45° FOV.
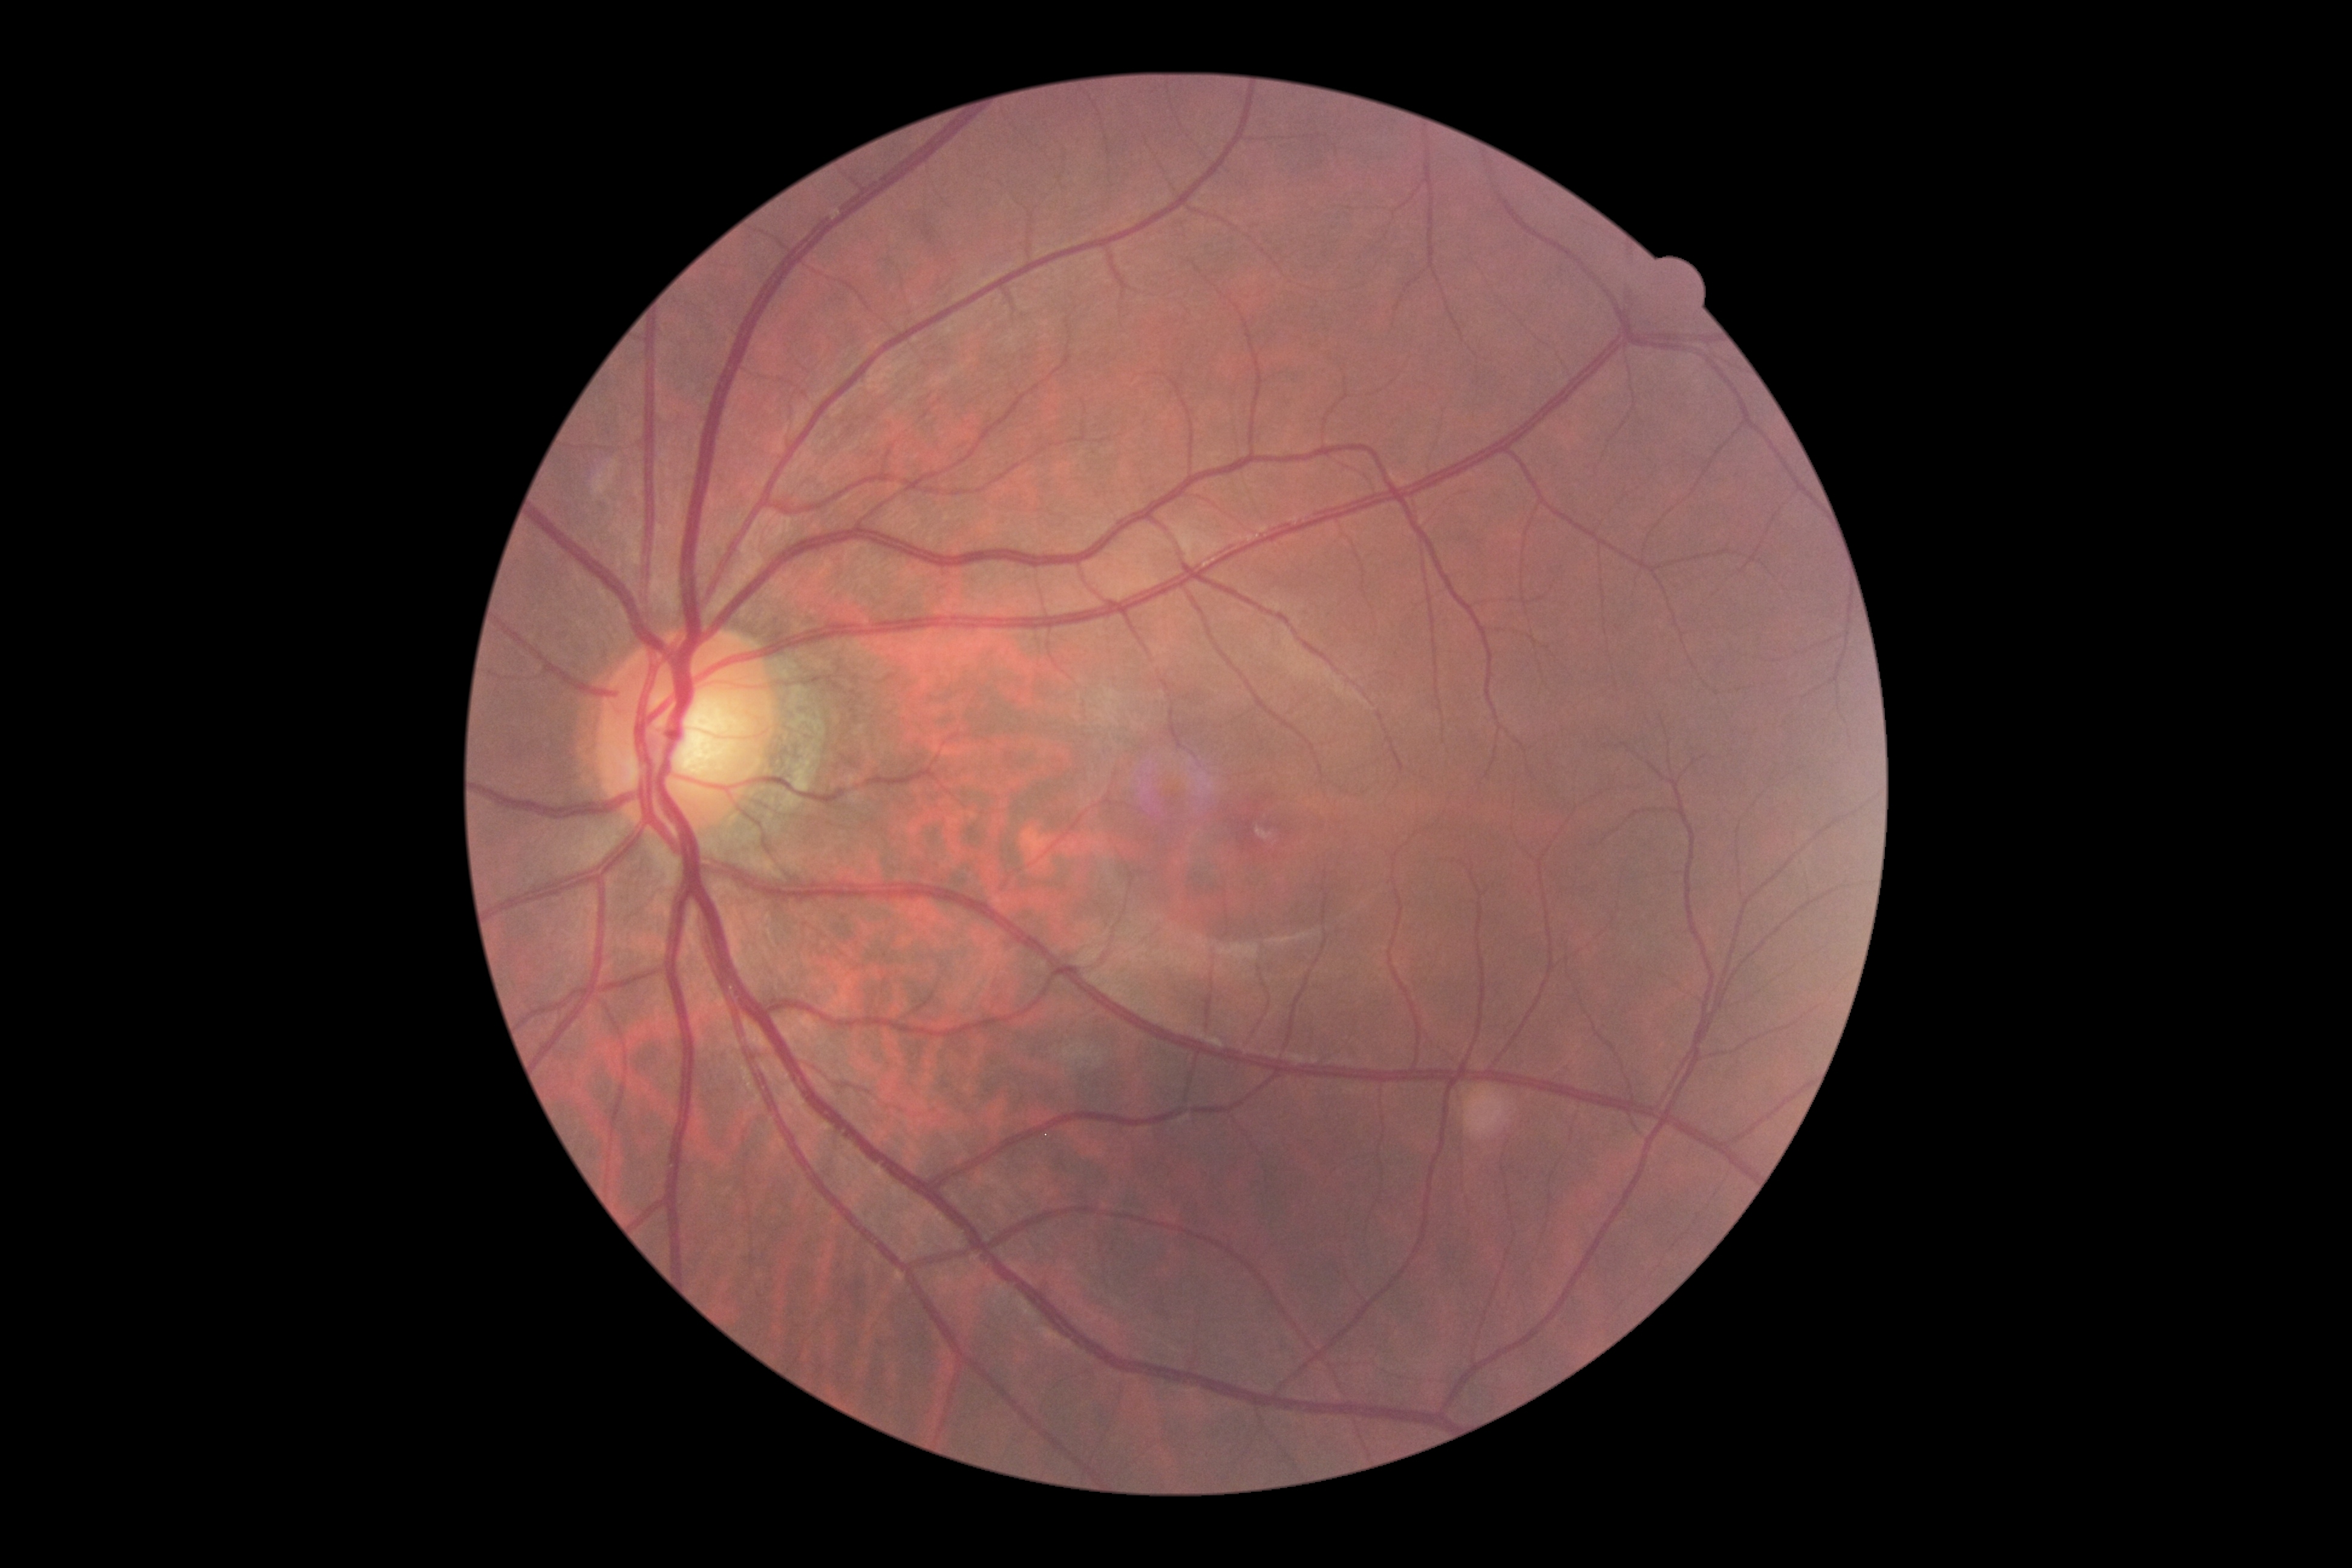

DR grade: no apparent diabetic retinopathy (0); DR impression: negative for DR.